Color fundus photograph.
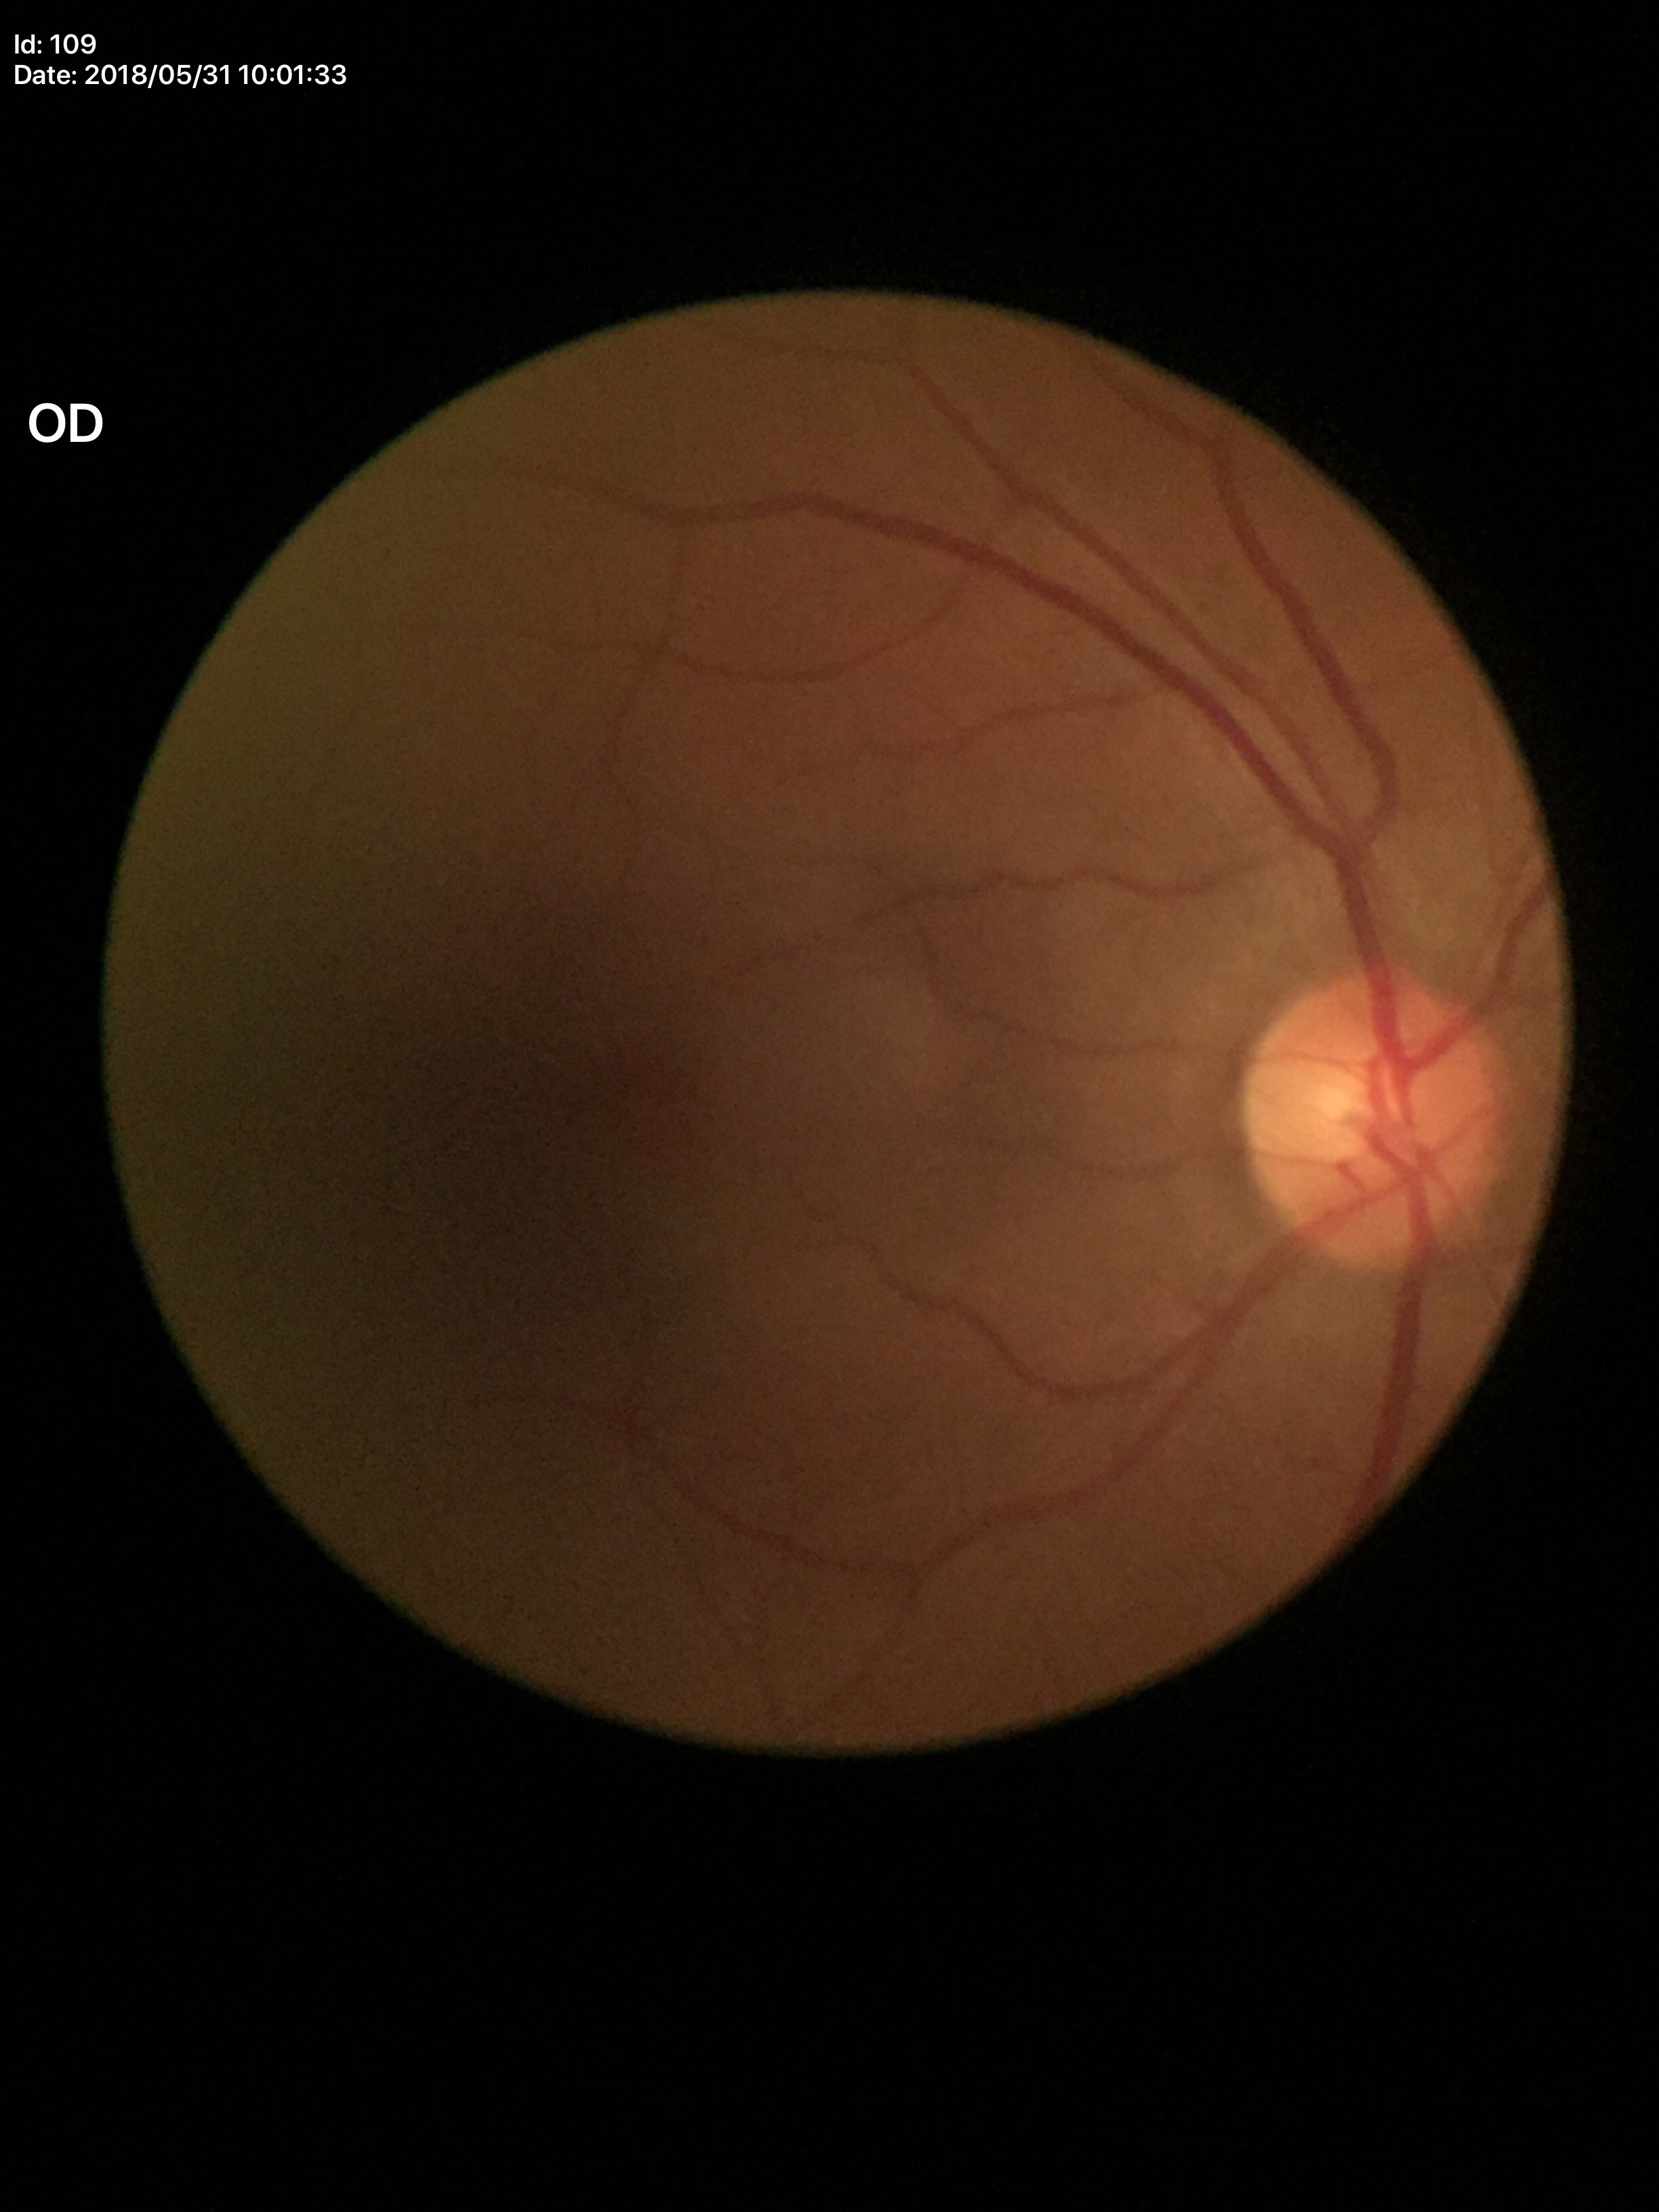
Glaucoma evaluation: no suspicious findings, area C/D ratio (ACDR): 0.25, vertical cup-disc ratio (VCDR): 0.47.